1240 by 1240 pixels; infant wide-field retinal image.
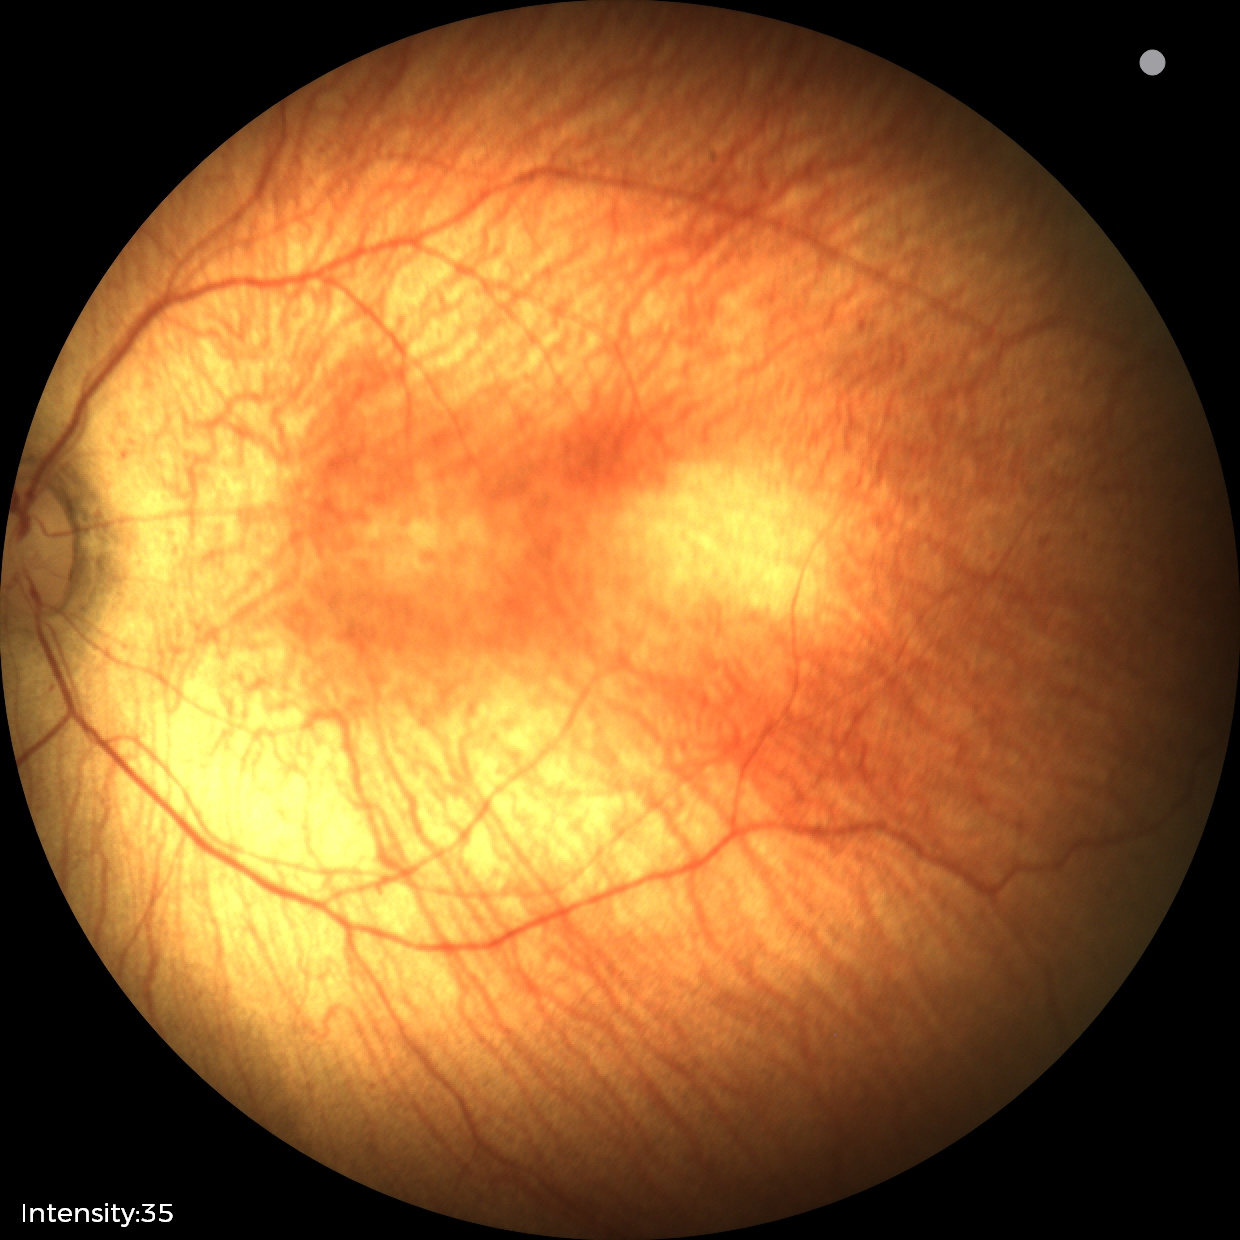 Without plus disease.
From an examination with diagnosis of status post retinopathy of prematurity.